FOV: 45 degrees, retinal fundus photograph, image size 848x848.
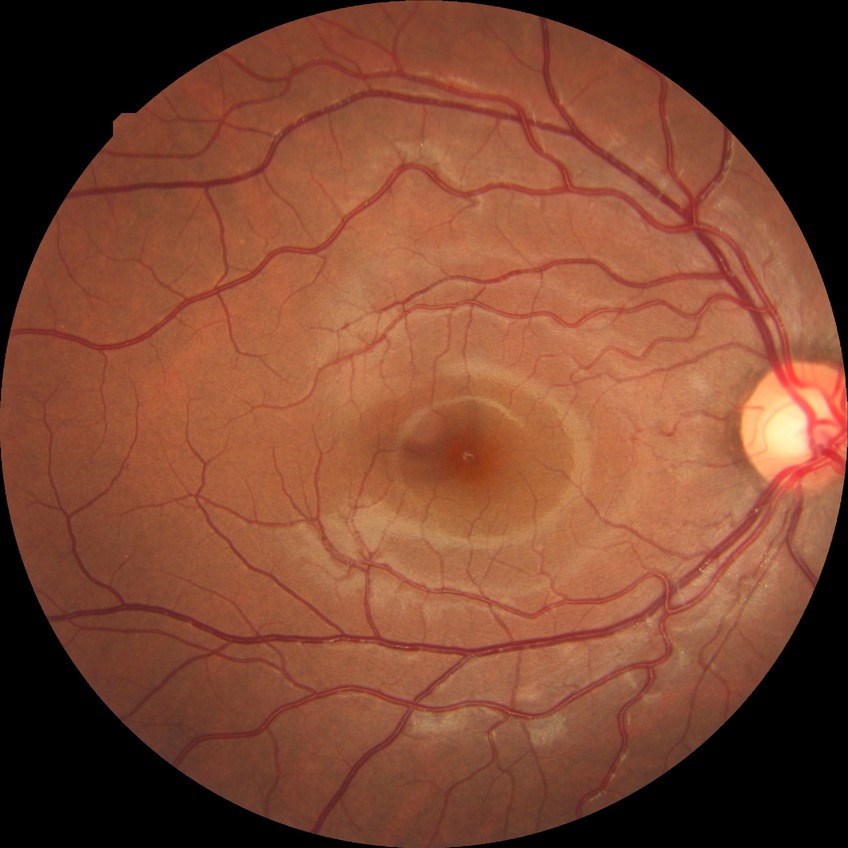

DR: NDR.